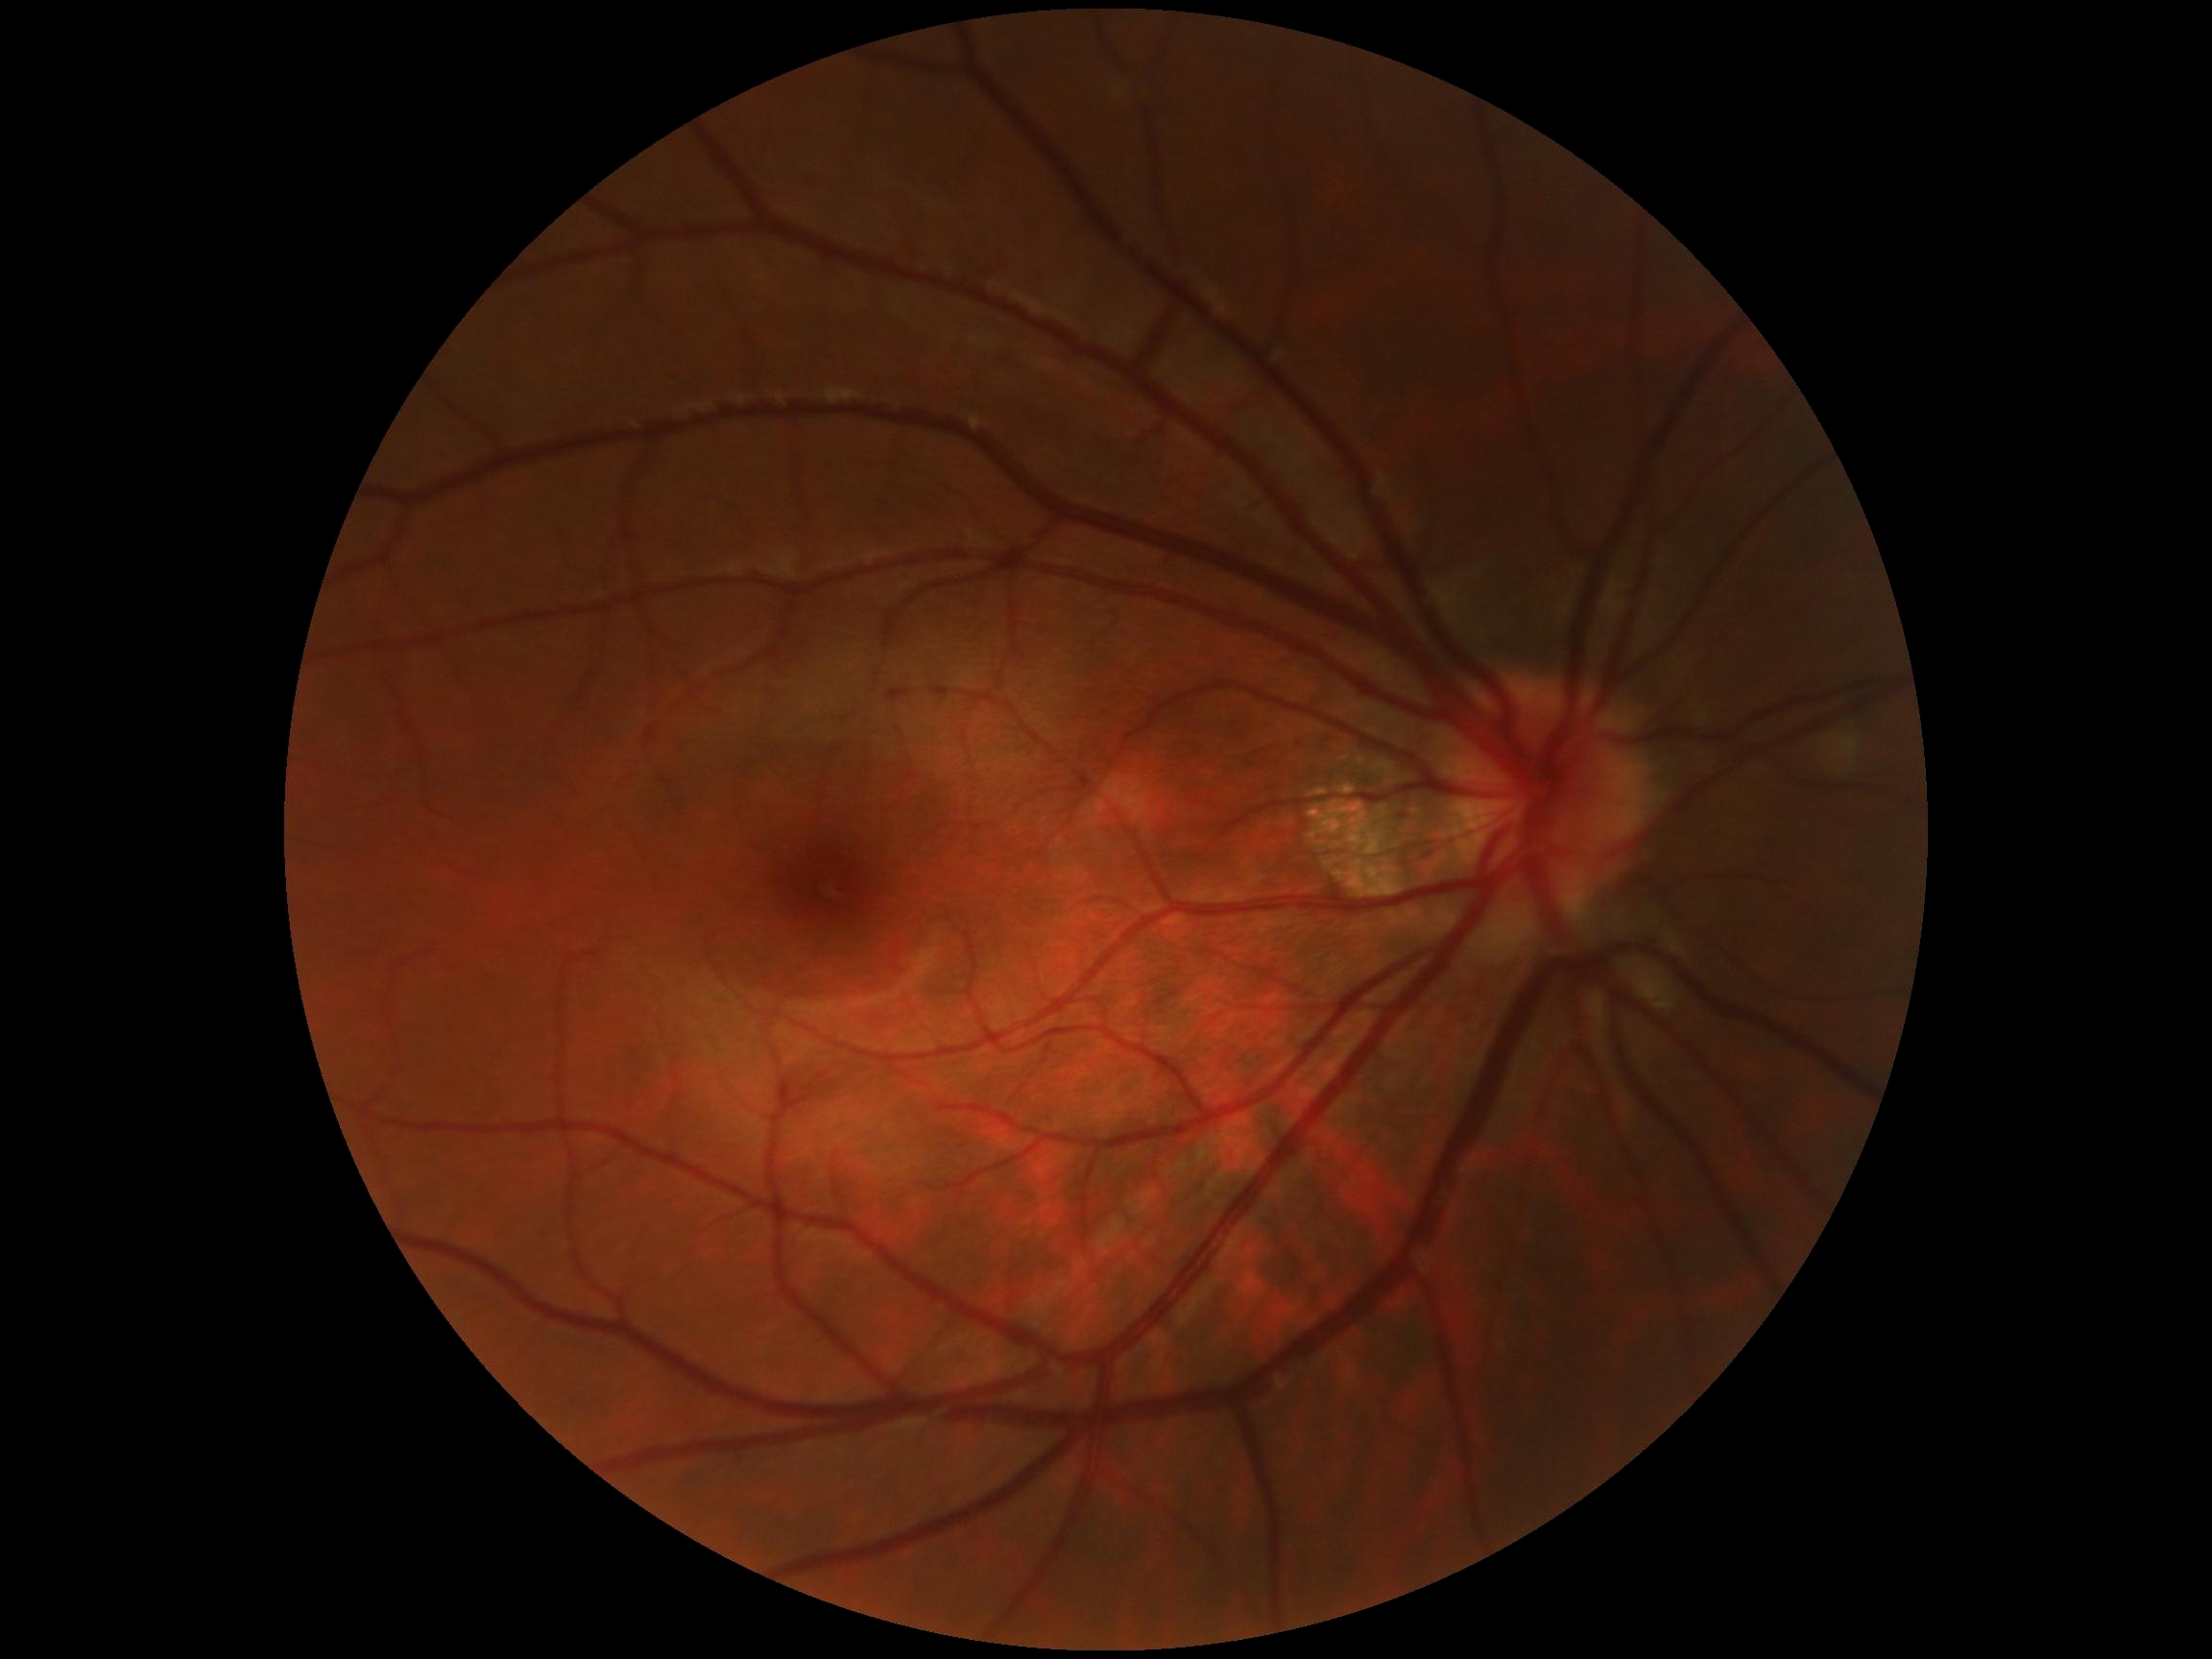
Diabetic retinopathy (DR): no apparent retinopathy (grade 0) — no visible signs of diabetic retinopathy.